Davis DR grading:
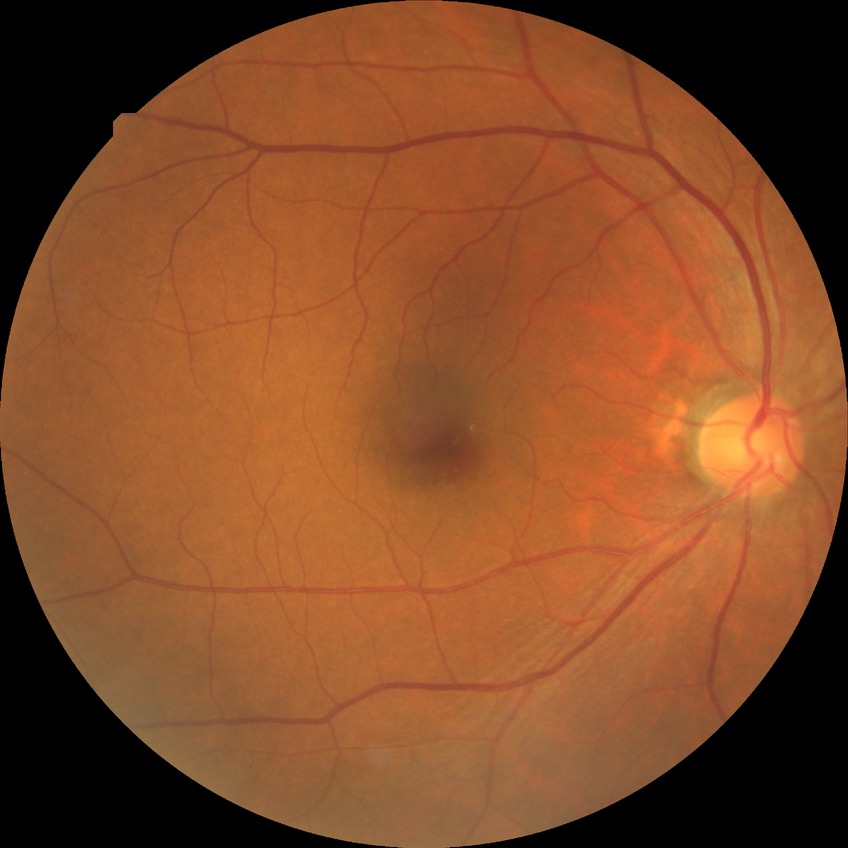 Diabetic retinopathy (DR) is no diabetic retinopathy (NDR).